Macula-centered; acquired with a Kowa VX-10α:
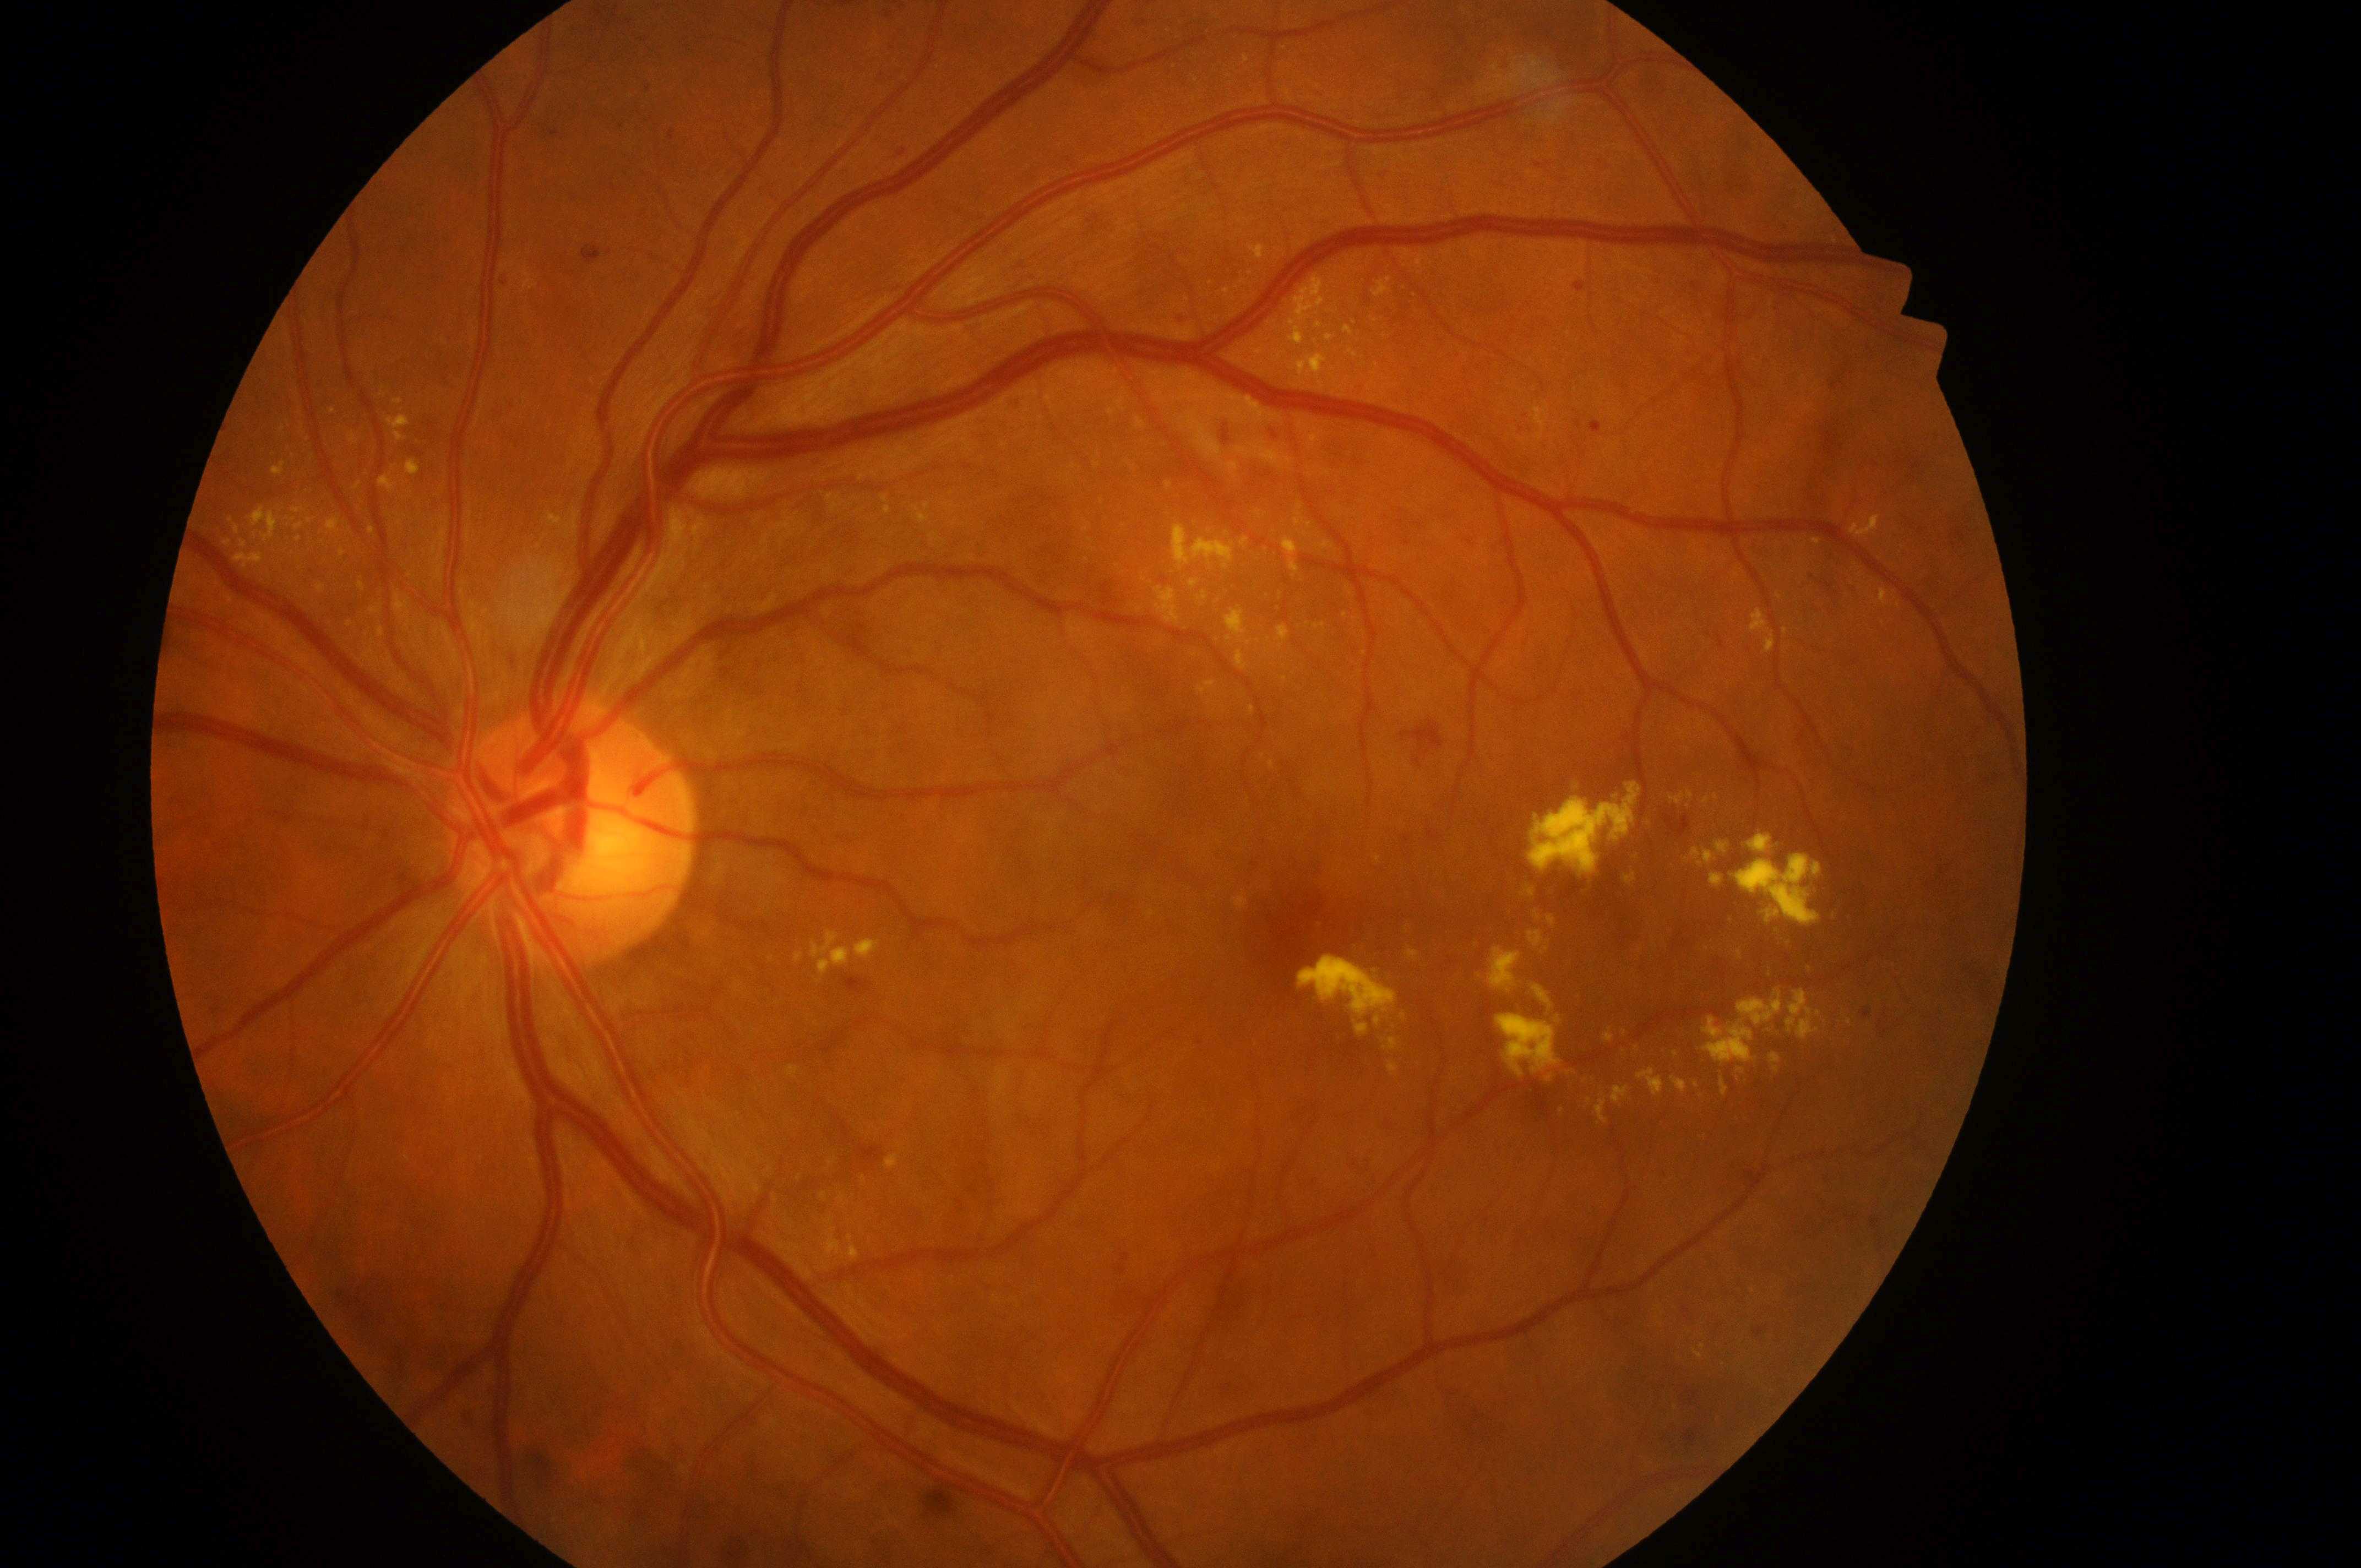
OS
disc center: [569, 845]
DME risk: 2/2 — hard exudates within one disc diameter of the macula center
fovea: [1305, 930]
DR severity: grade 2 — more than just microaneurysms but less than severe NPDR